Image size 2228x1652 · FOV: 50 degrees — 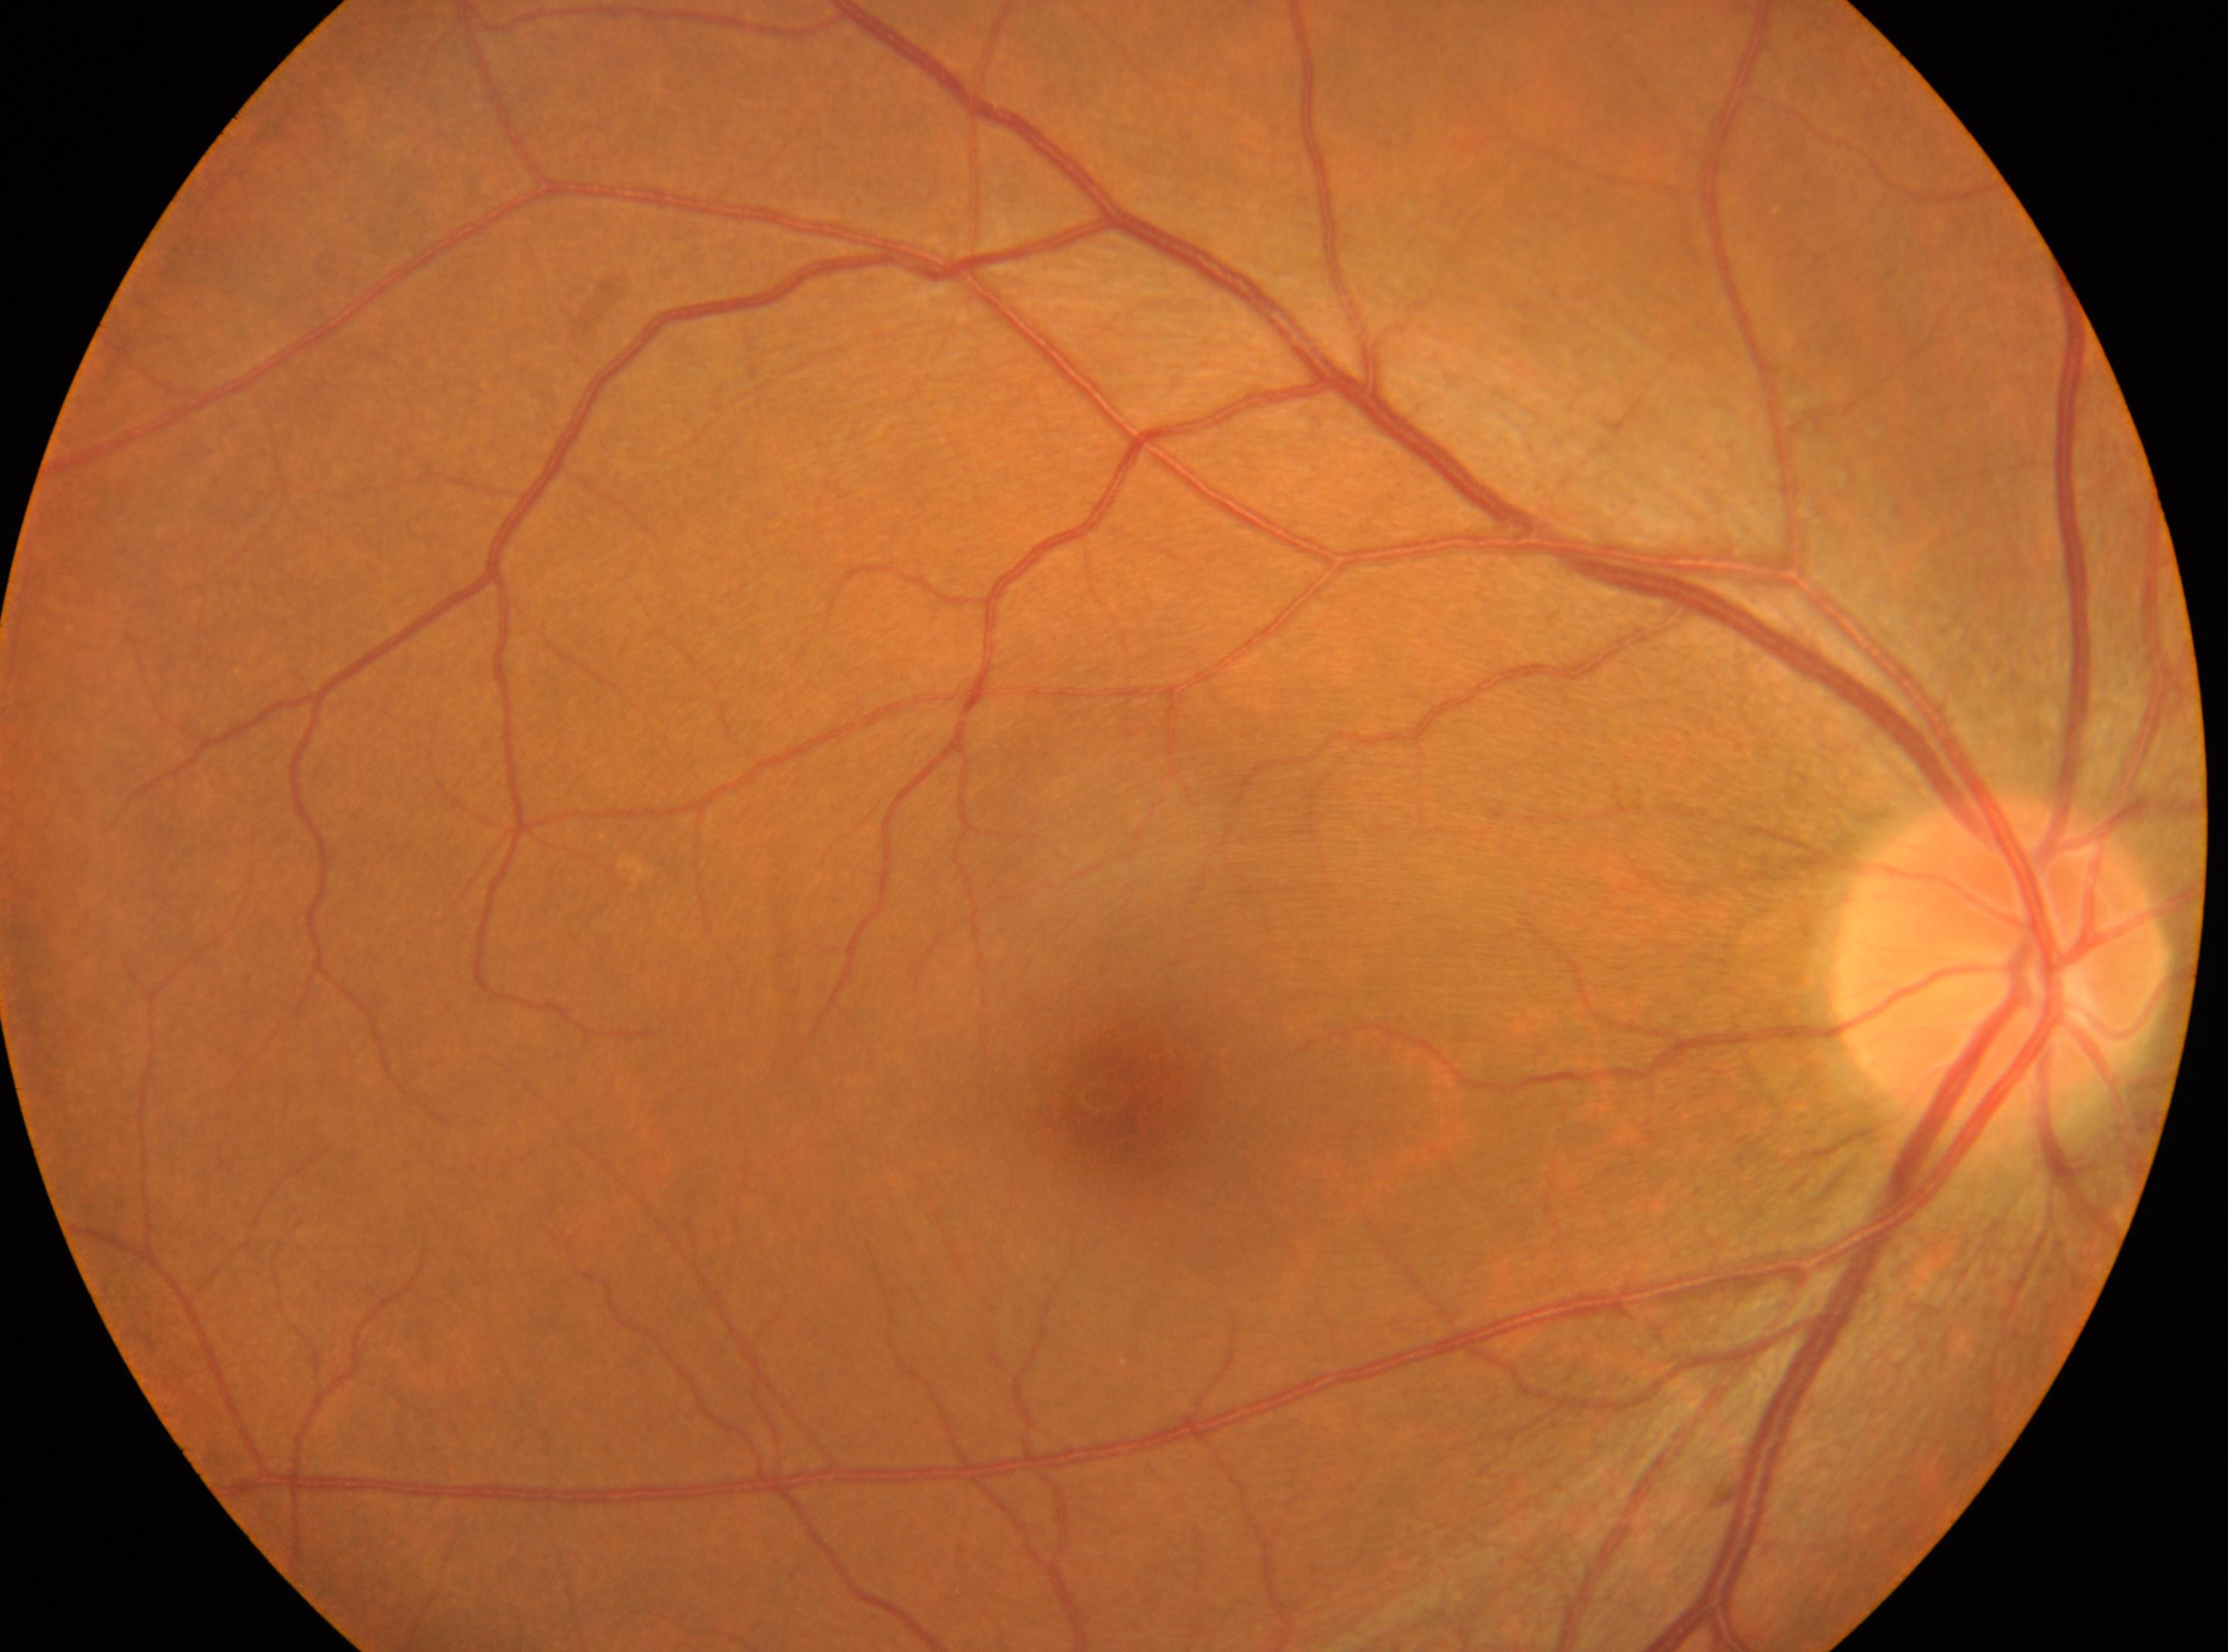
The image shows the right eye.
Diabetic retinopathy (DR) is grade 0 (no apparent retinopathy).
The ONH is at (1997,957).
Macular center: (1111,1095).
No diabetic retinopathy identified.